Captured after pupil dilation — 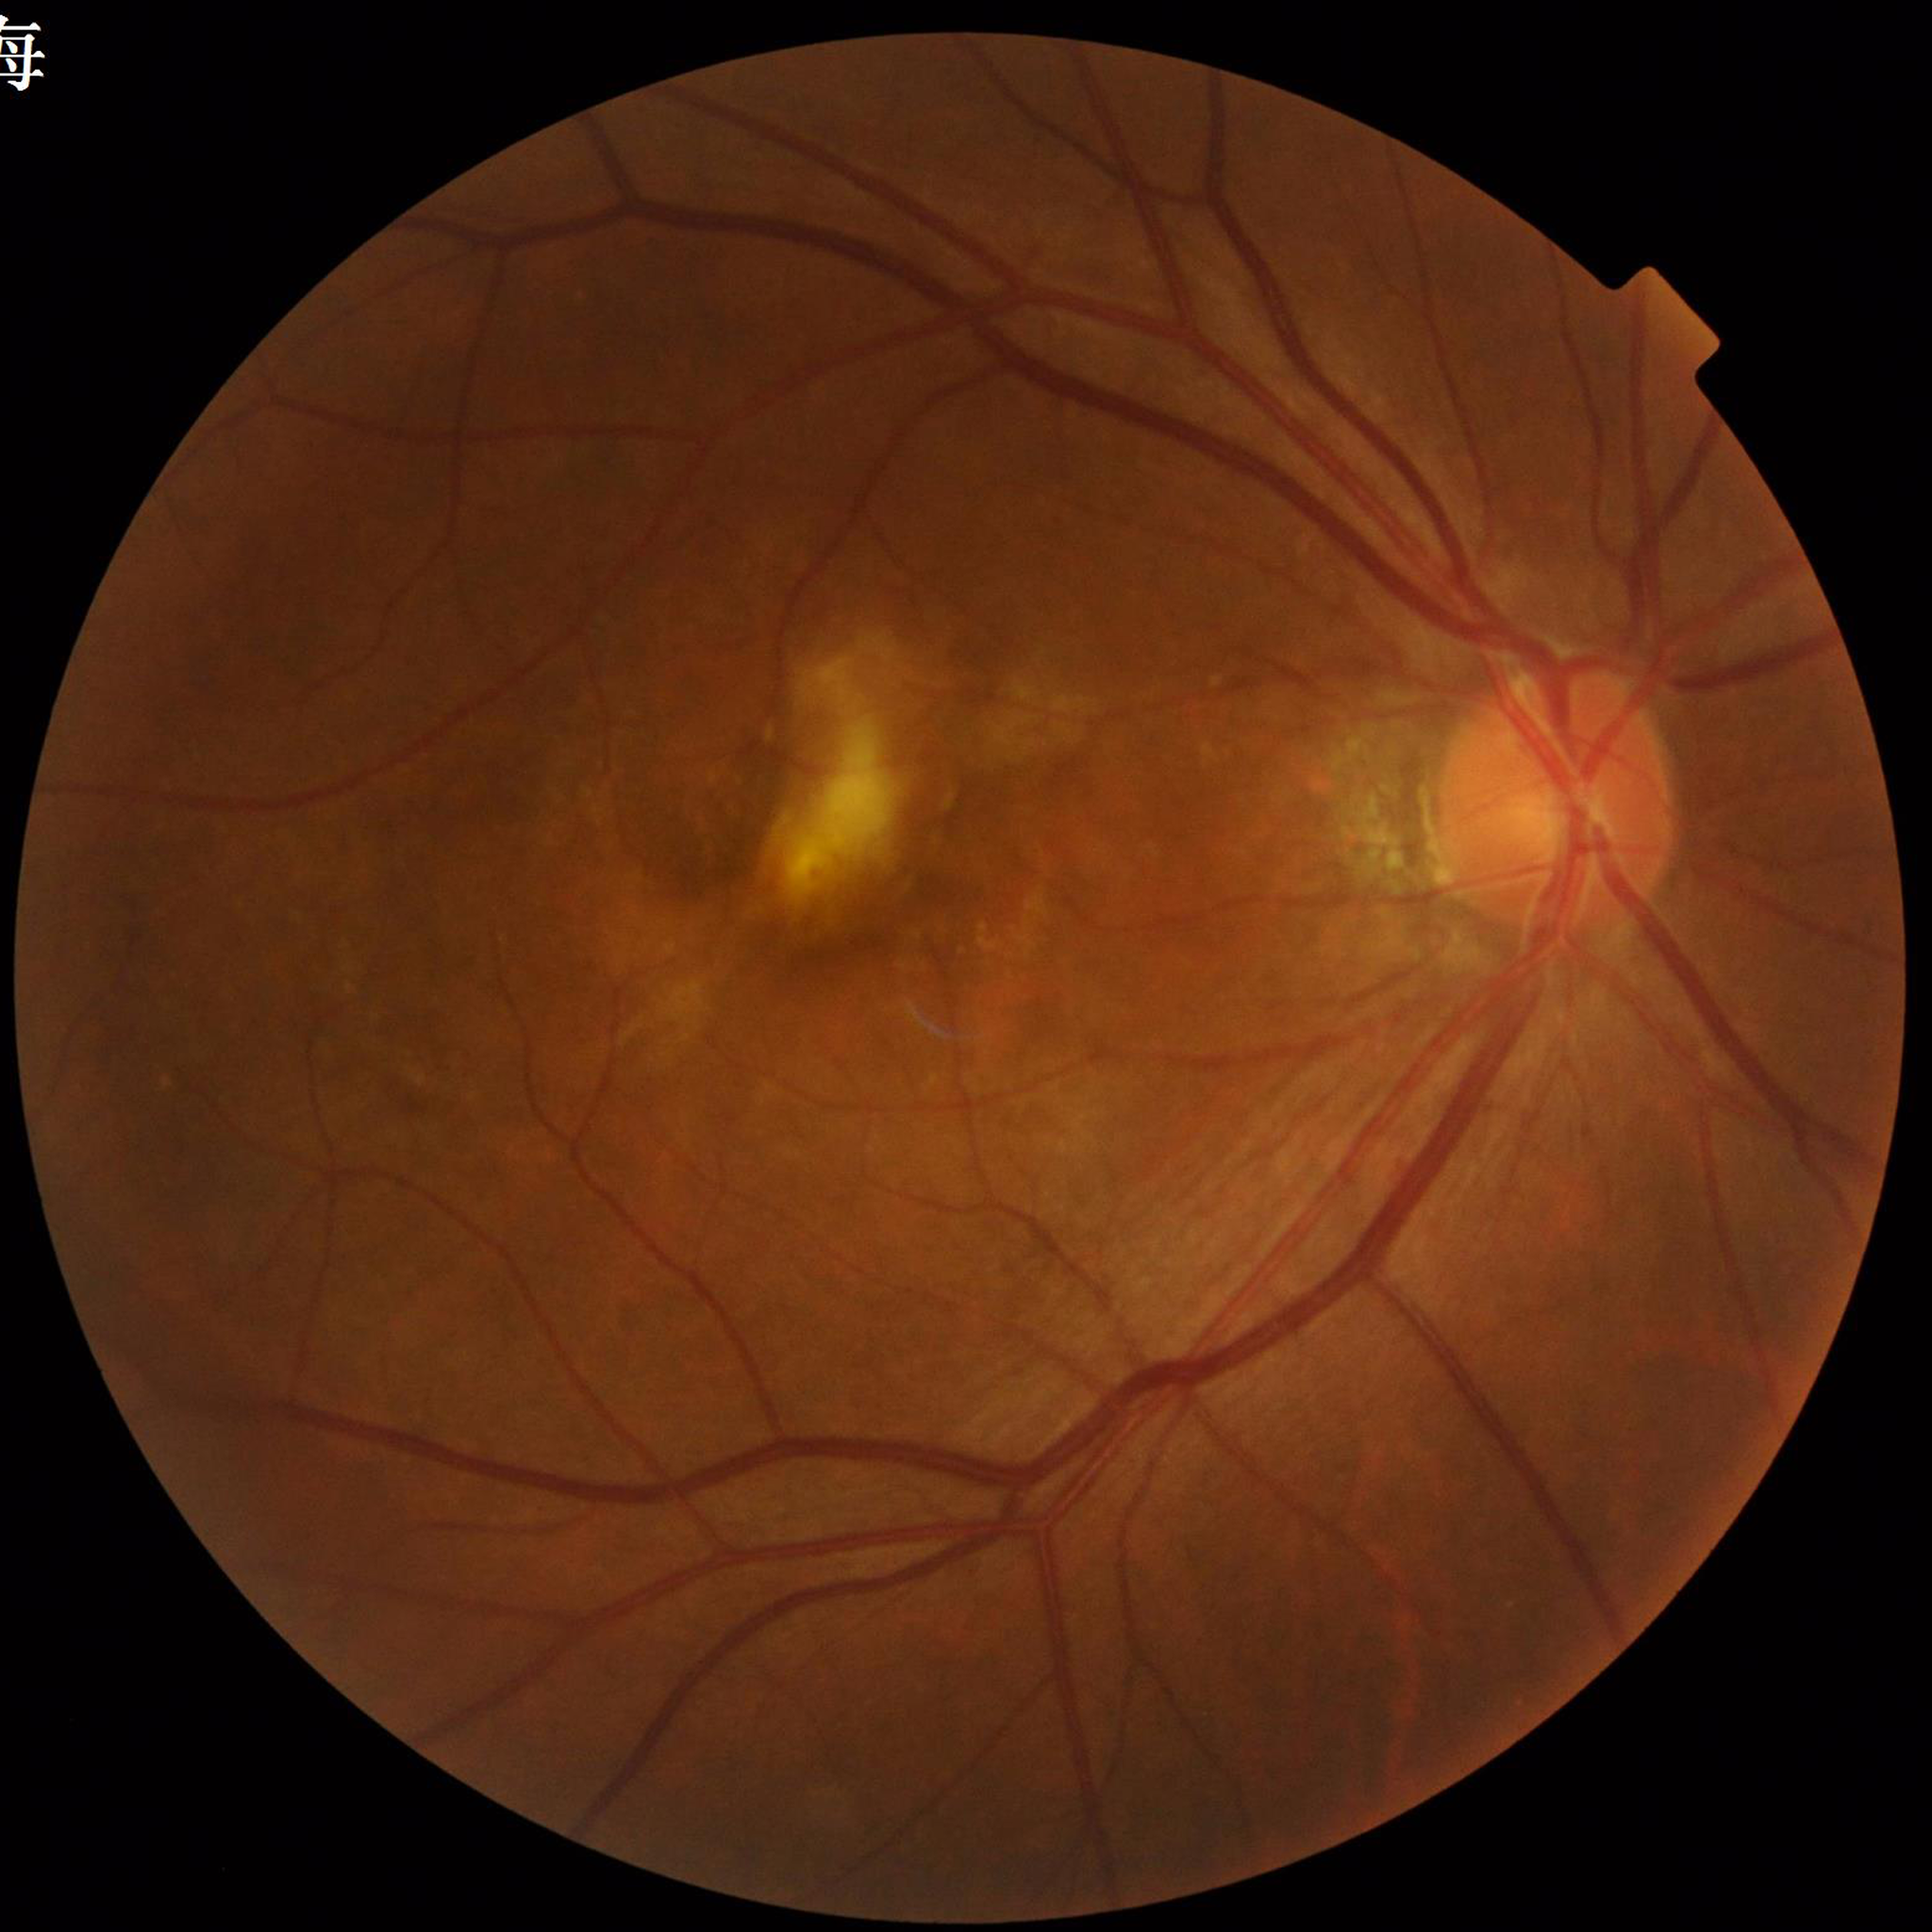 {"diagnosis": "age-related macular degeneration"}